Infant wide-field fundus photograph
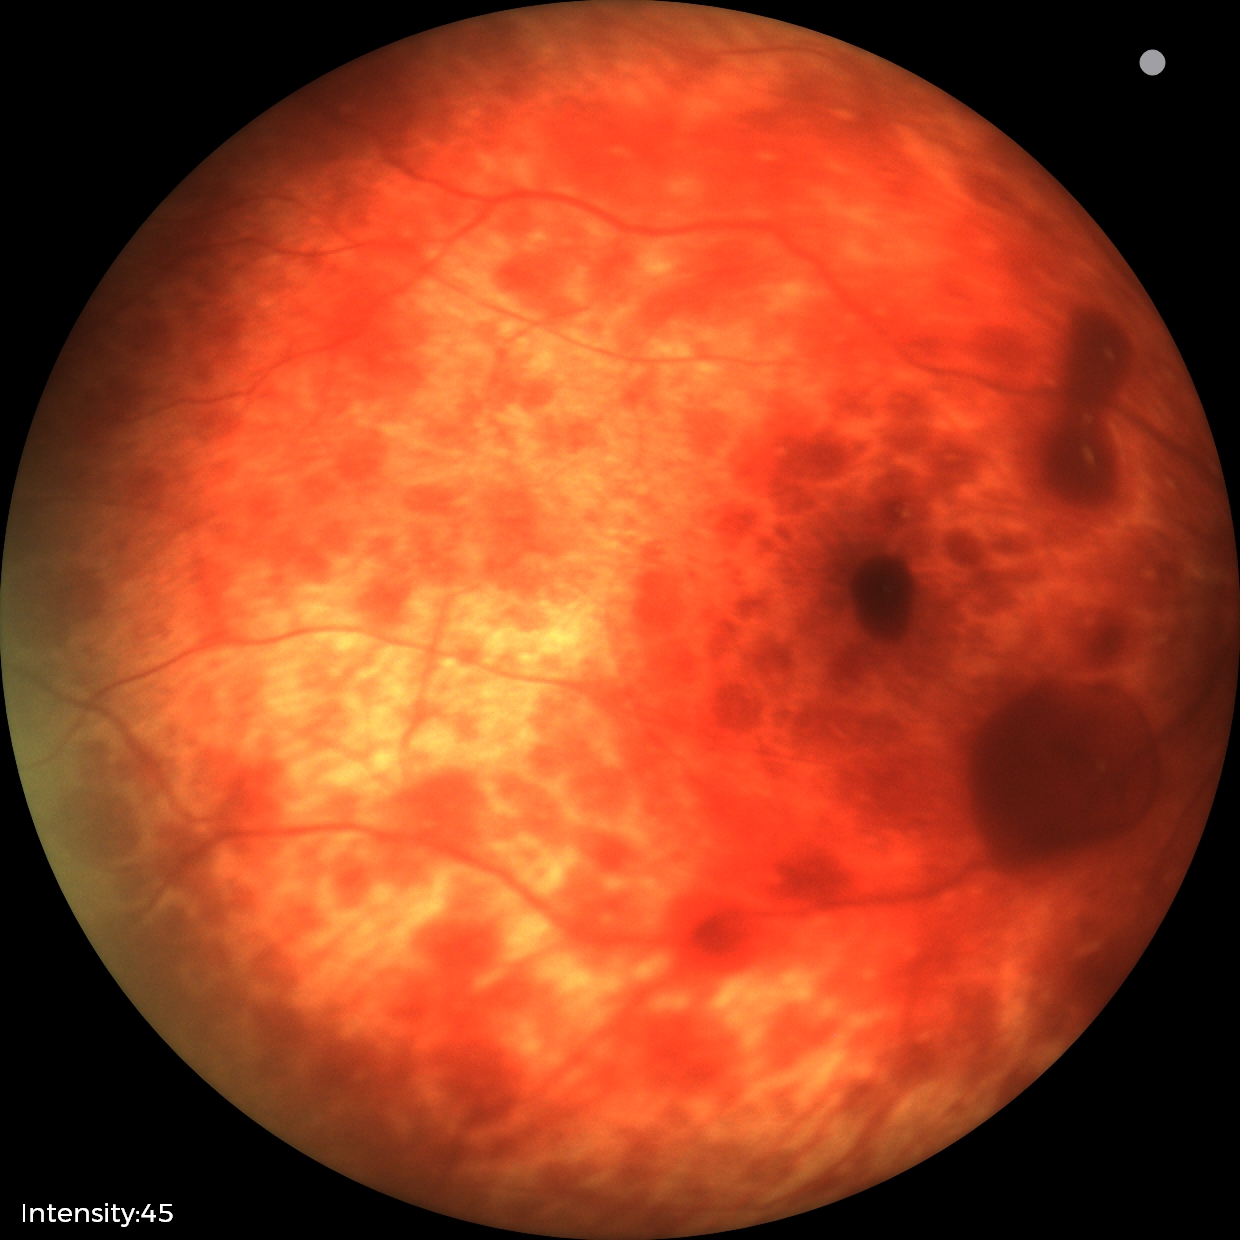
Diagnosis from this screening exam: retinal hemorrhages.